45° FOV; 2212x1659: 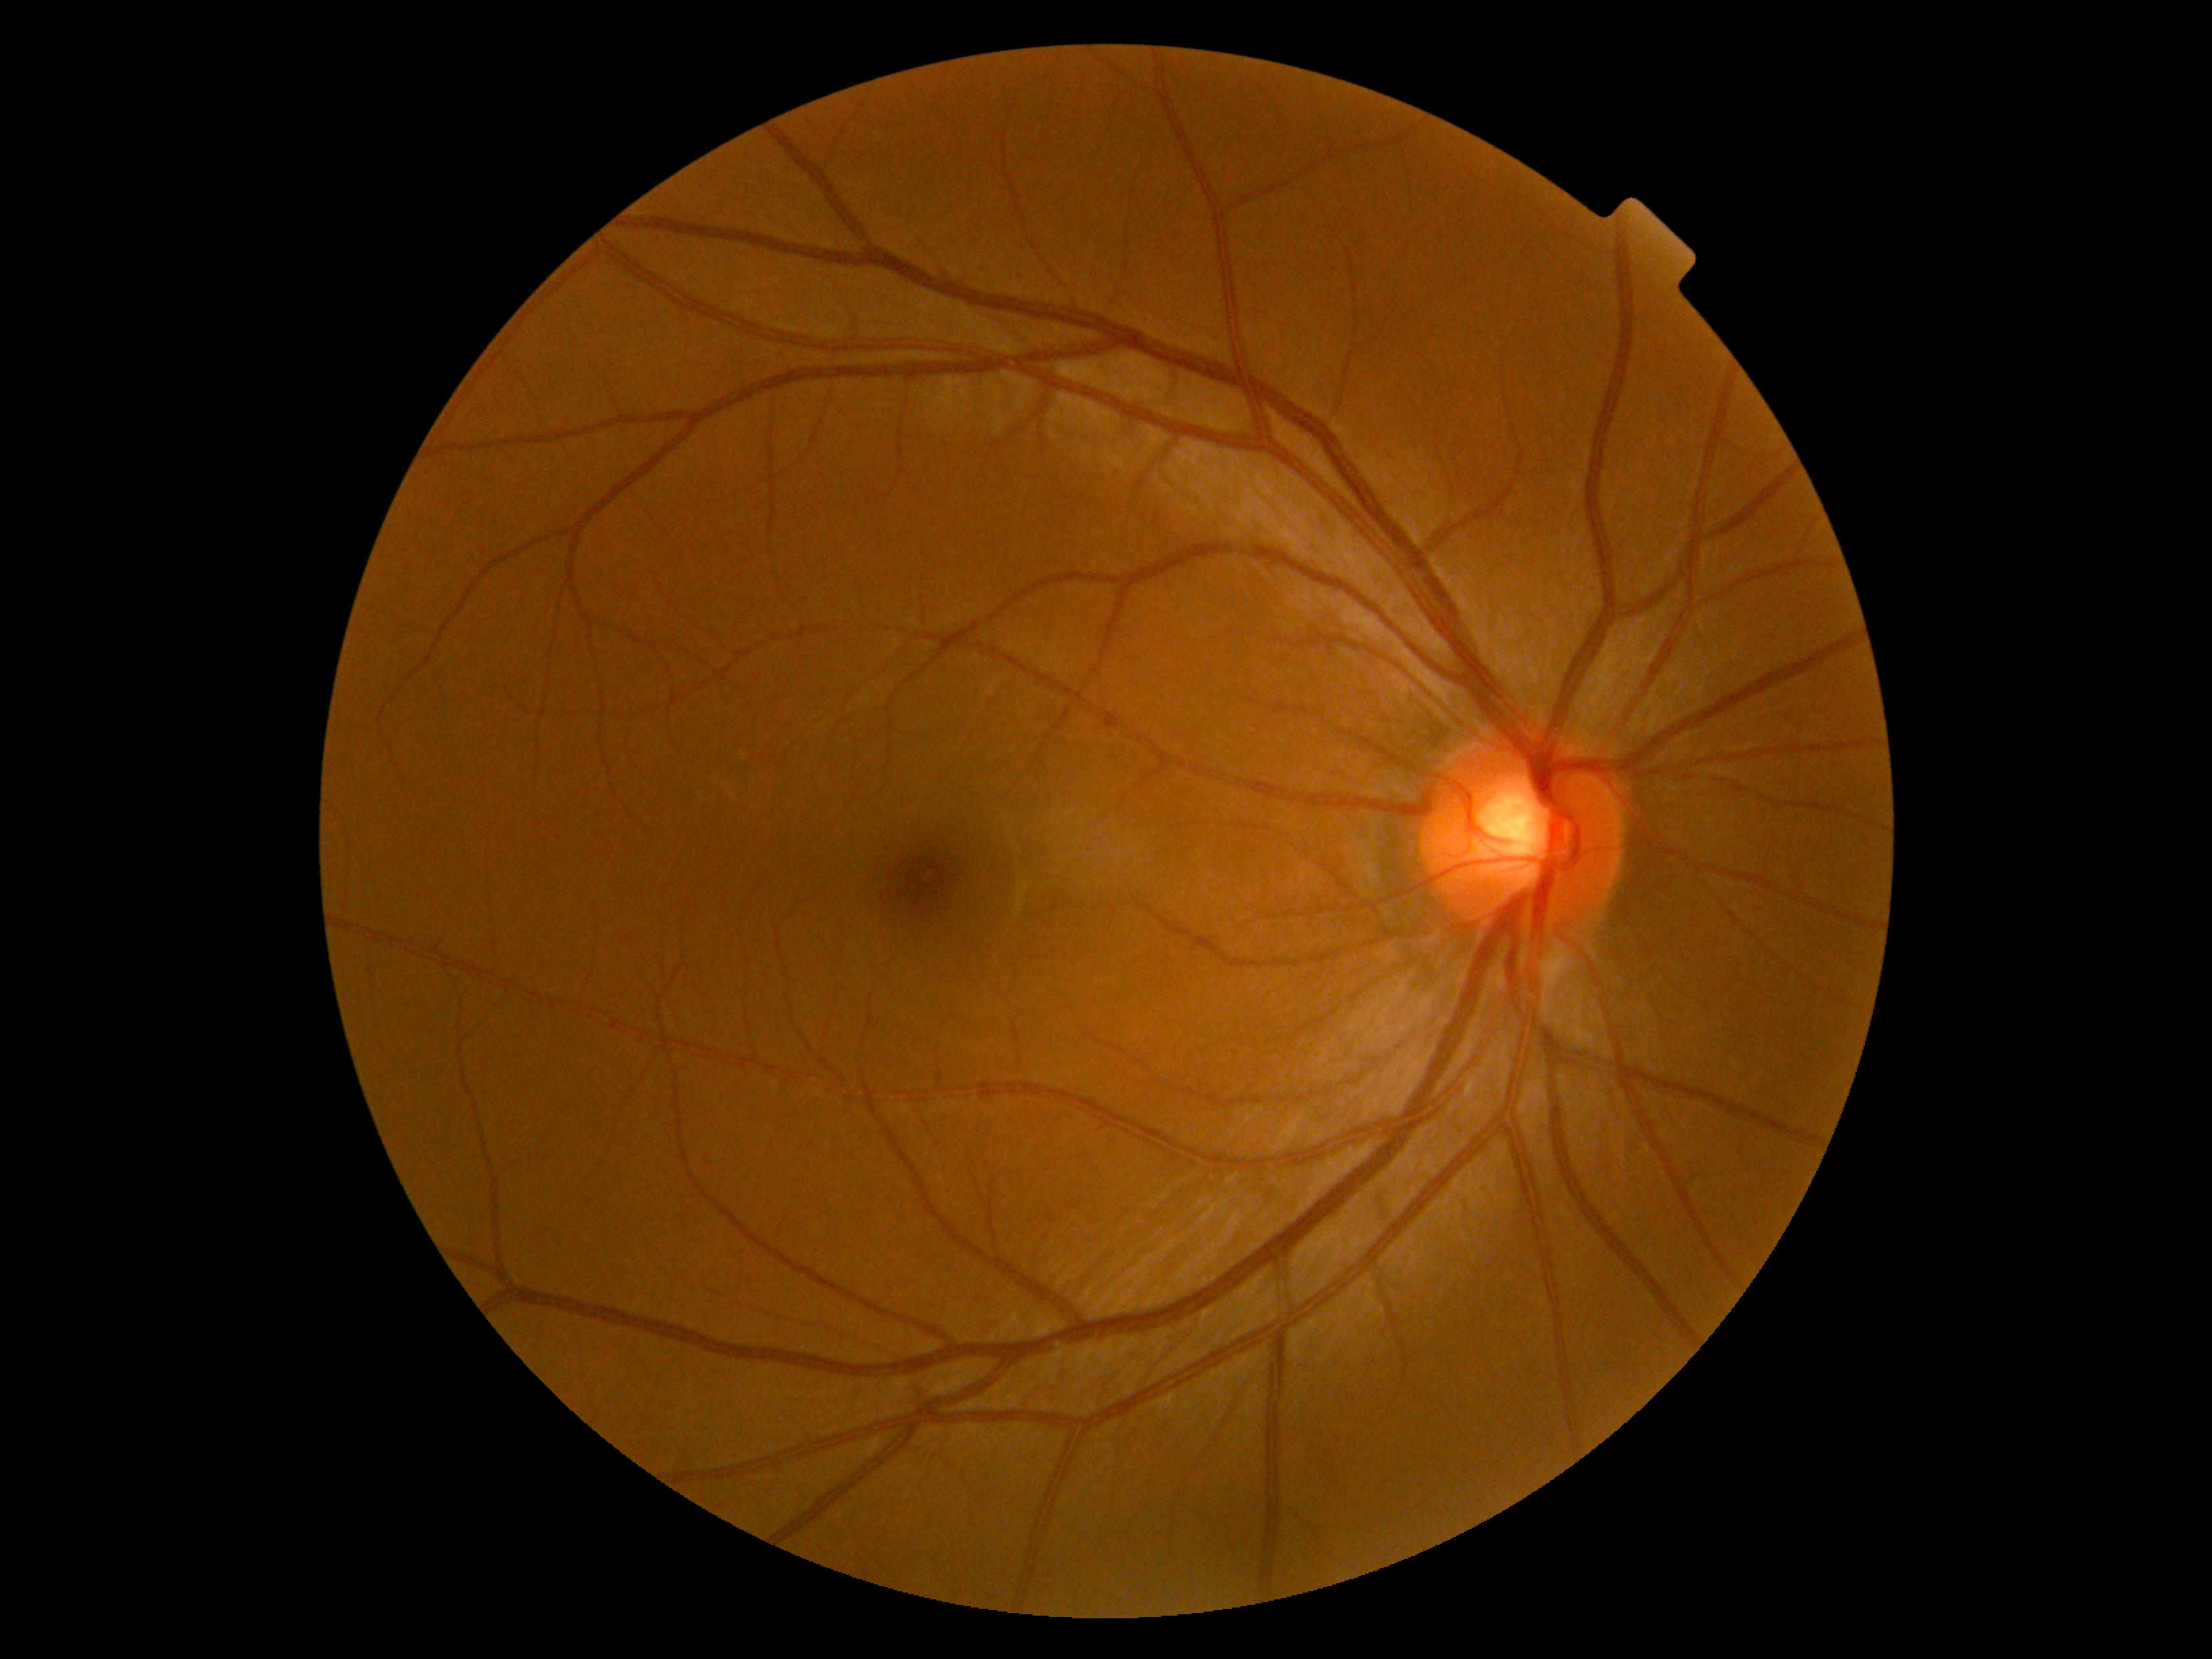 {
  "dr_grade": "no apparent diabetic retinopathy (grade 0) — no visible signs of diabetic retinopathy",
  "dr_impression": "no signs of DR"
}